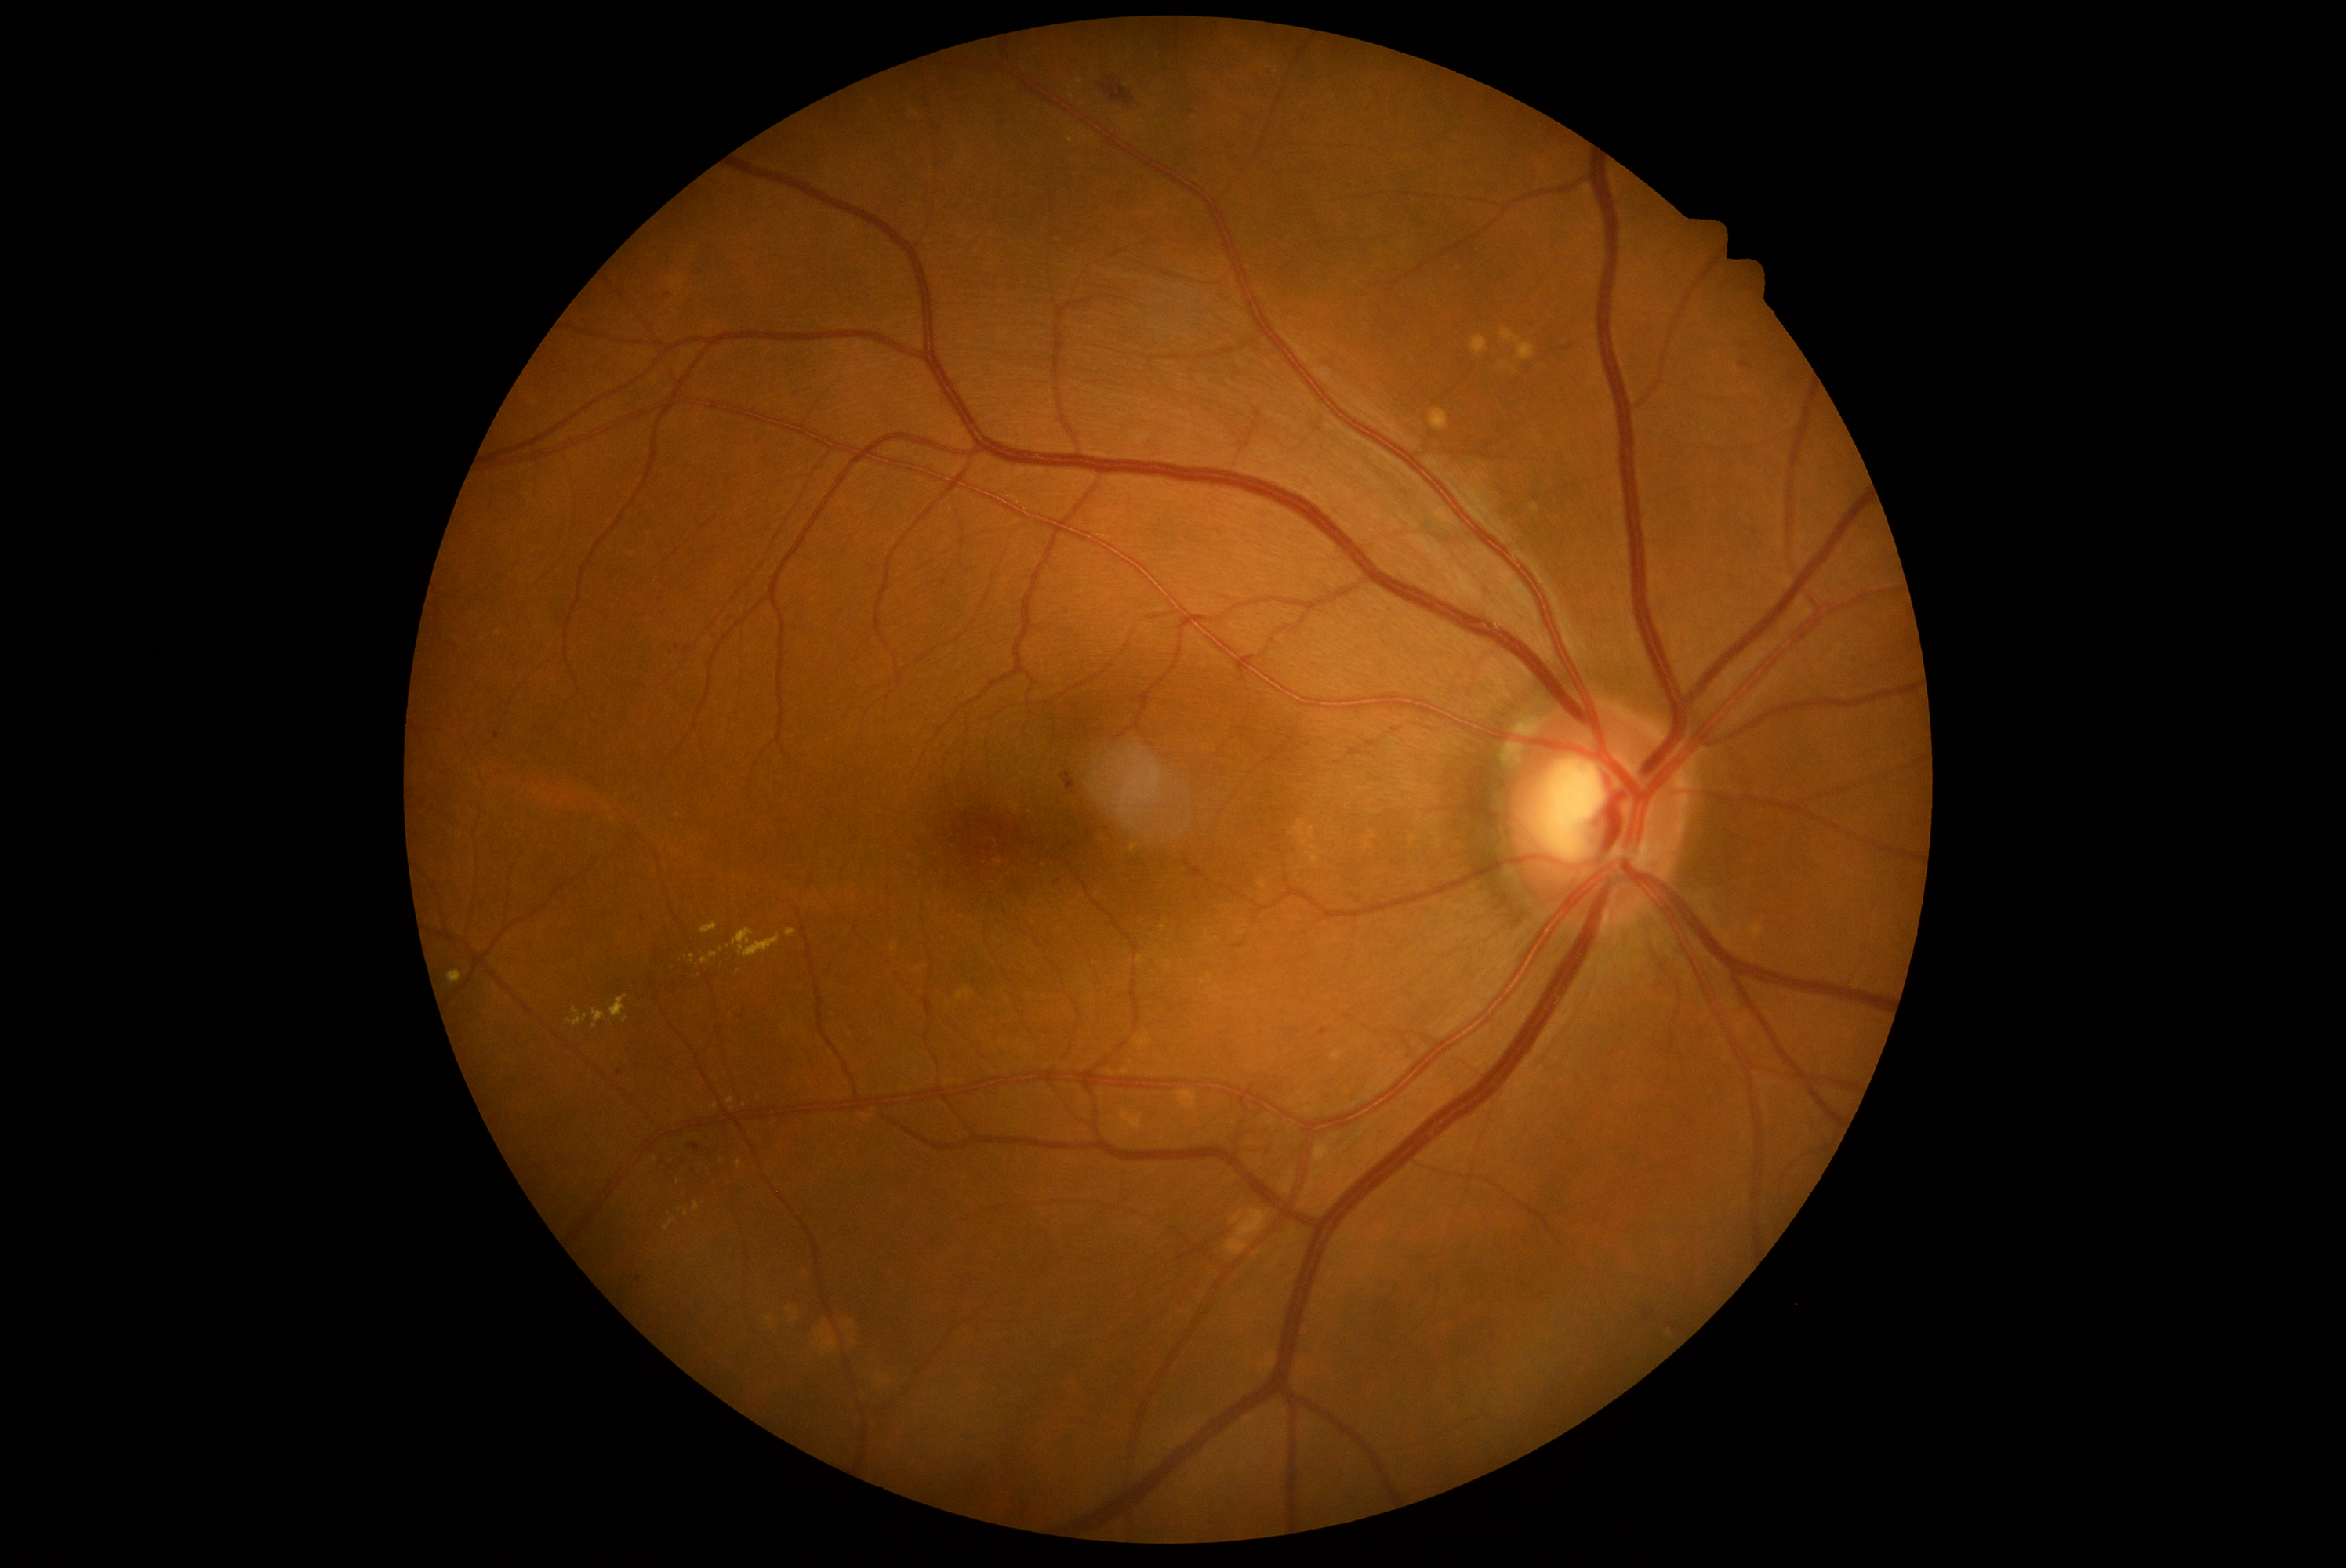 Diabetic retinopathy grade is 2 (moderate NPDR); non-proliferative diabetic retinopathy
Lesions identified (partial list):
hard exudates (continued): <region>611, 996, 626, 1018</region> | <region>567, 1015, 587, 1026</region> | <region>692, 1203, 700, 1211</region> | <region>702, 923, 717, 935</region> | <region>689, 954, 695, 964</region> | <region>664, 1219, 678, 1232</region>
Small hard exudates near (1134,849) | (576,1011) | (759,1098) | (738,973) | (1080,82) | (686,1213)